Color fundus photograph · 2212x1659 · 45-degree field of view
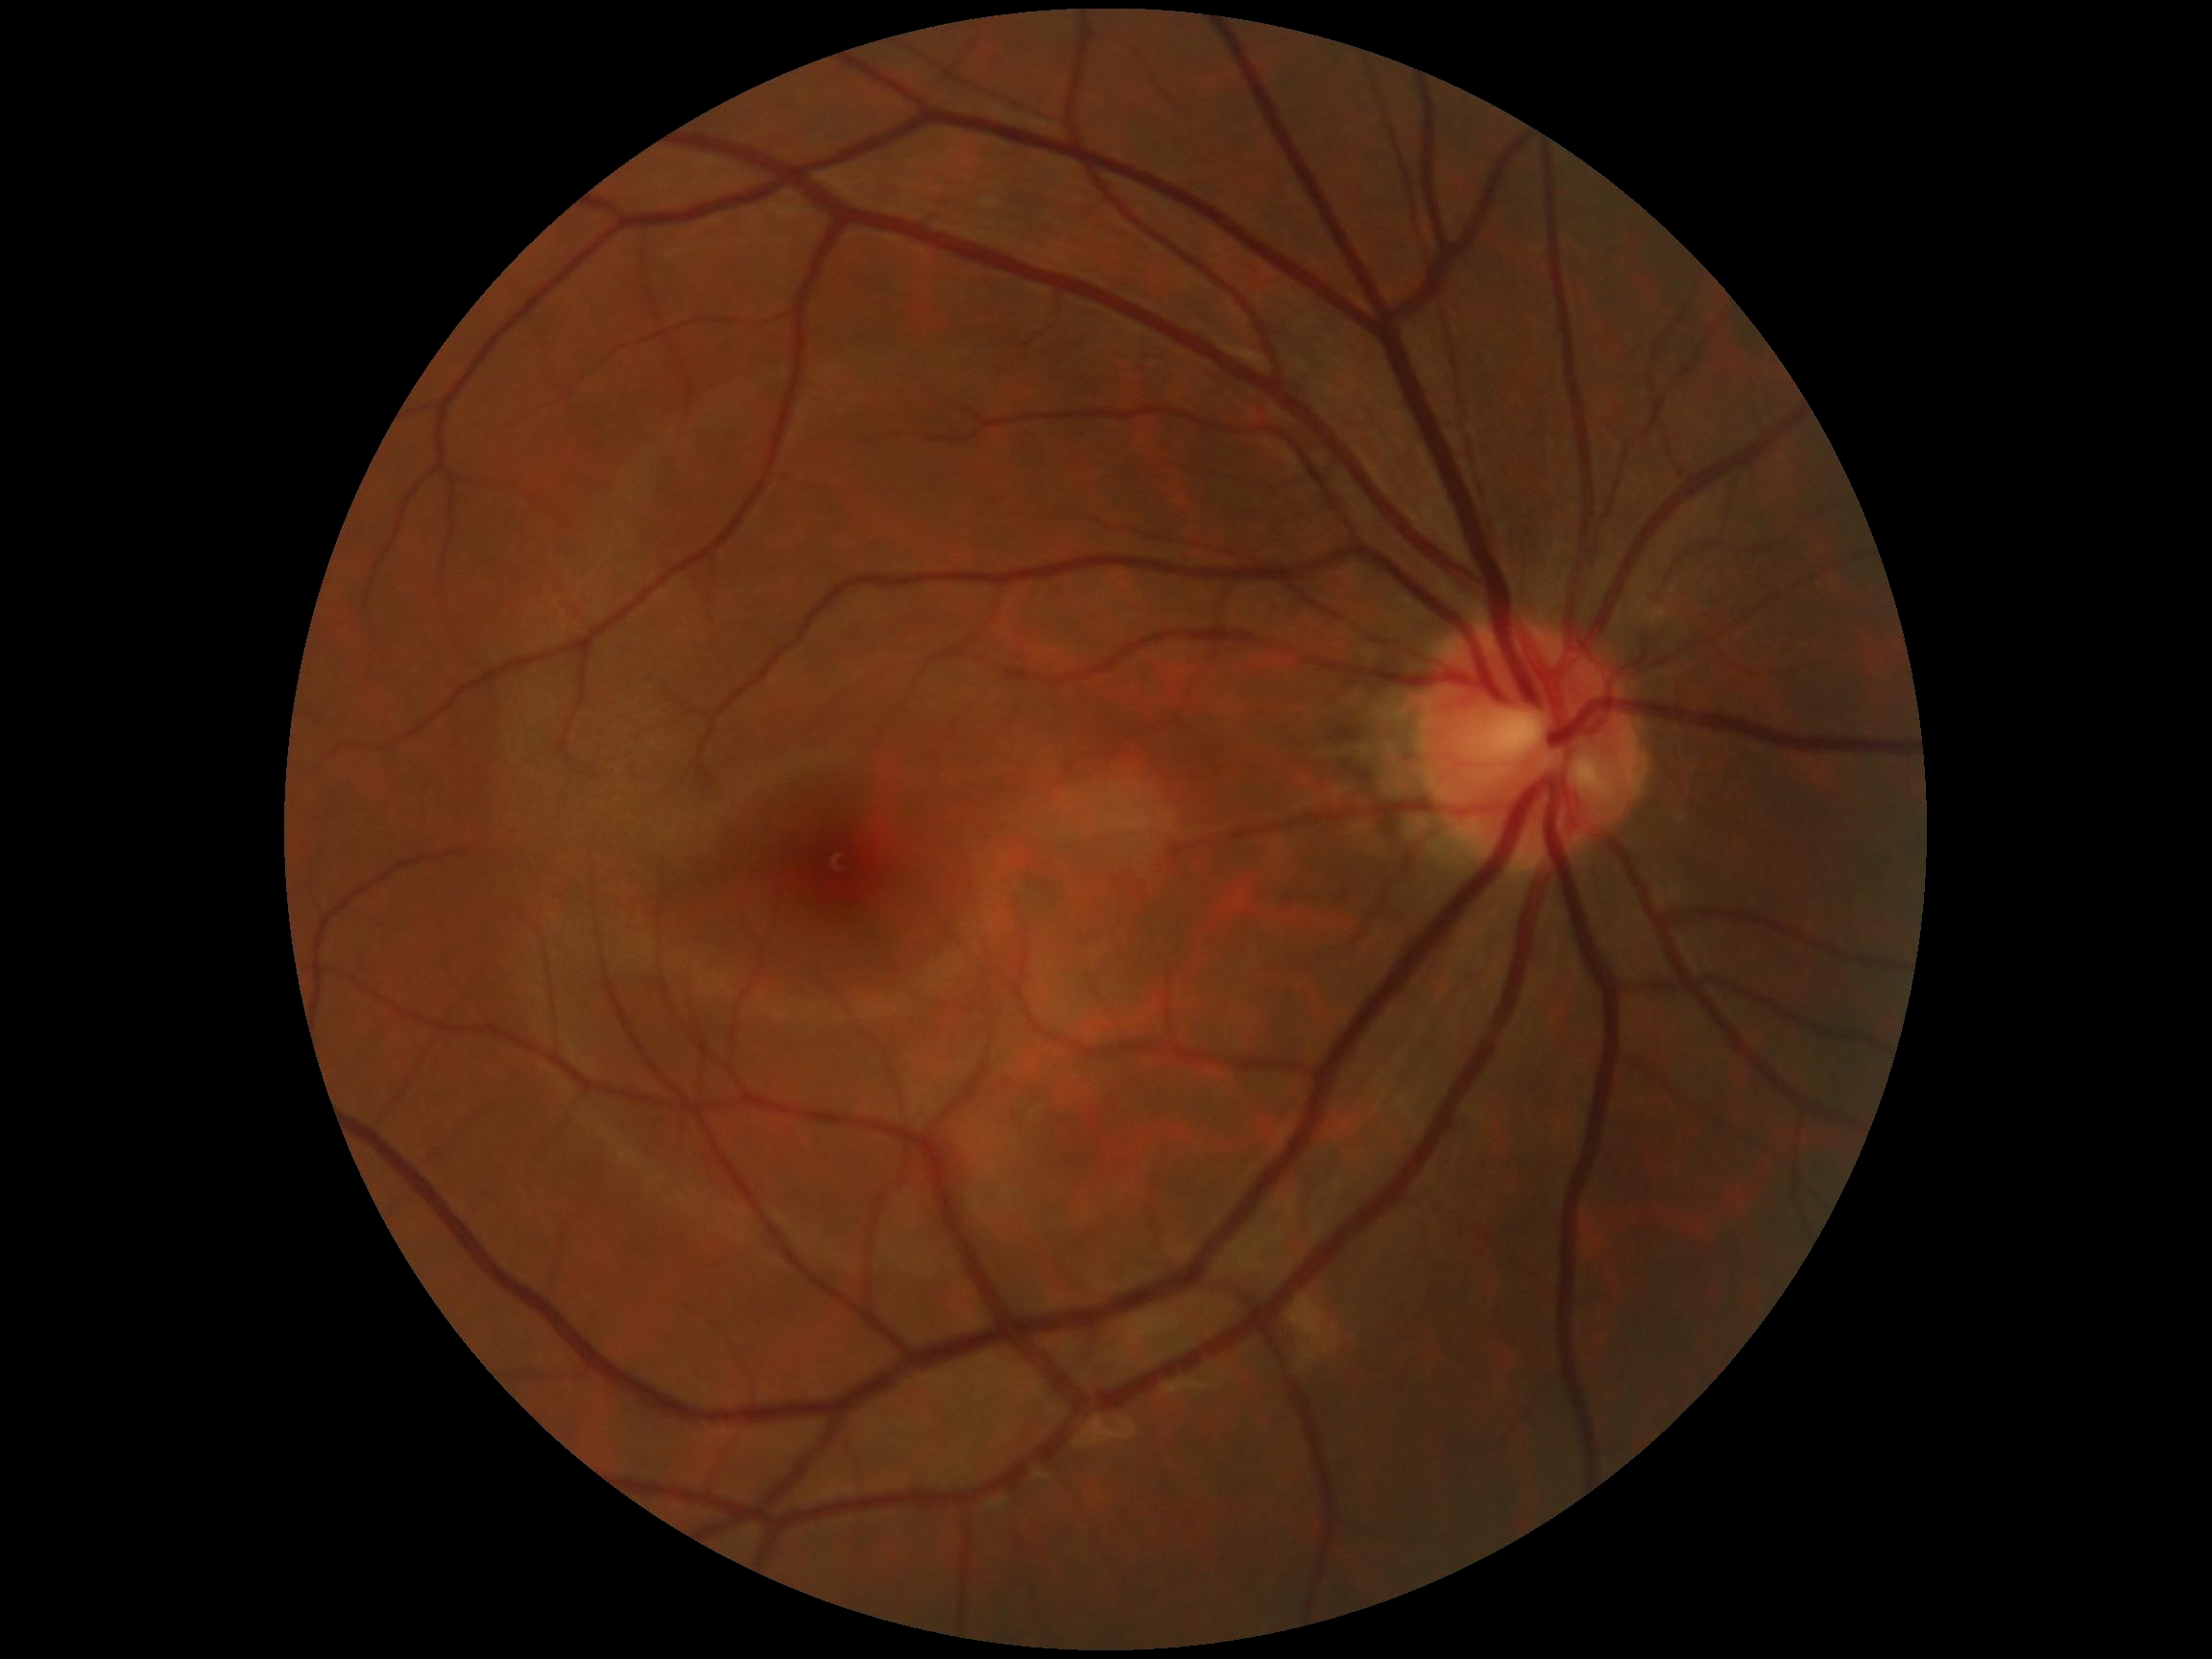

– diabetic retinopathy (DR): 0/4